45° FOV — 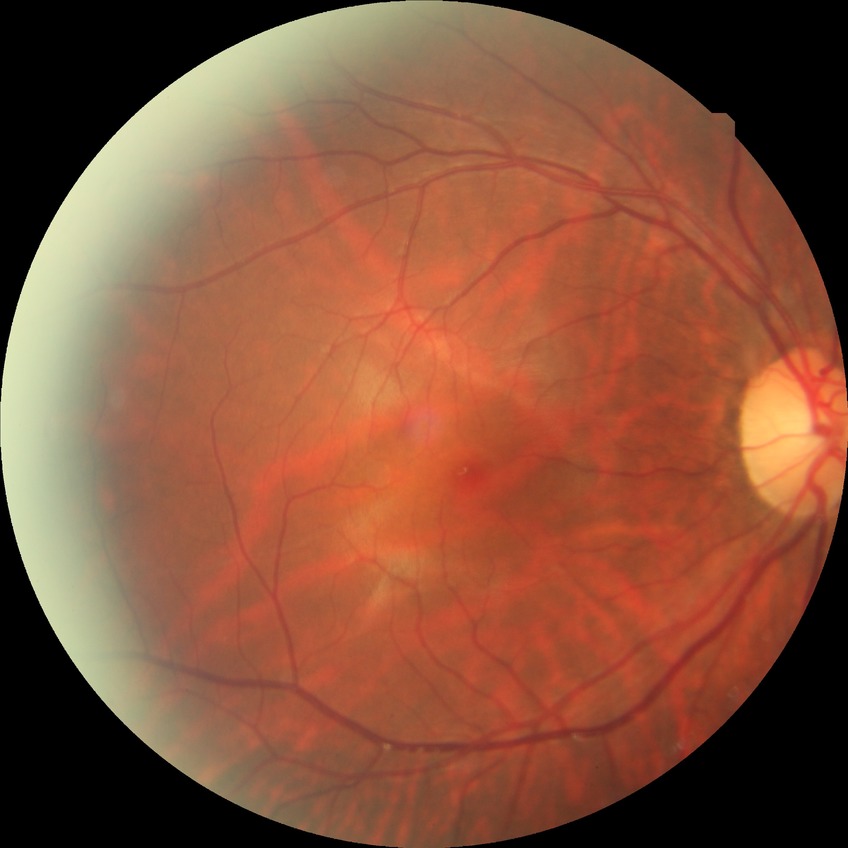
Diabetic retinopathy (DR) is NDR (no diabetic retinopathy).